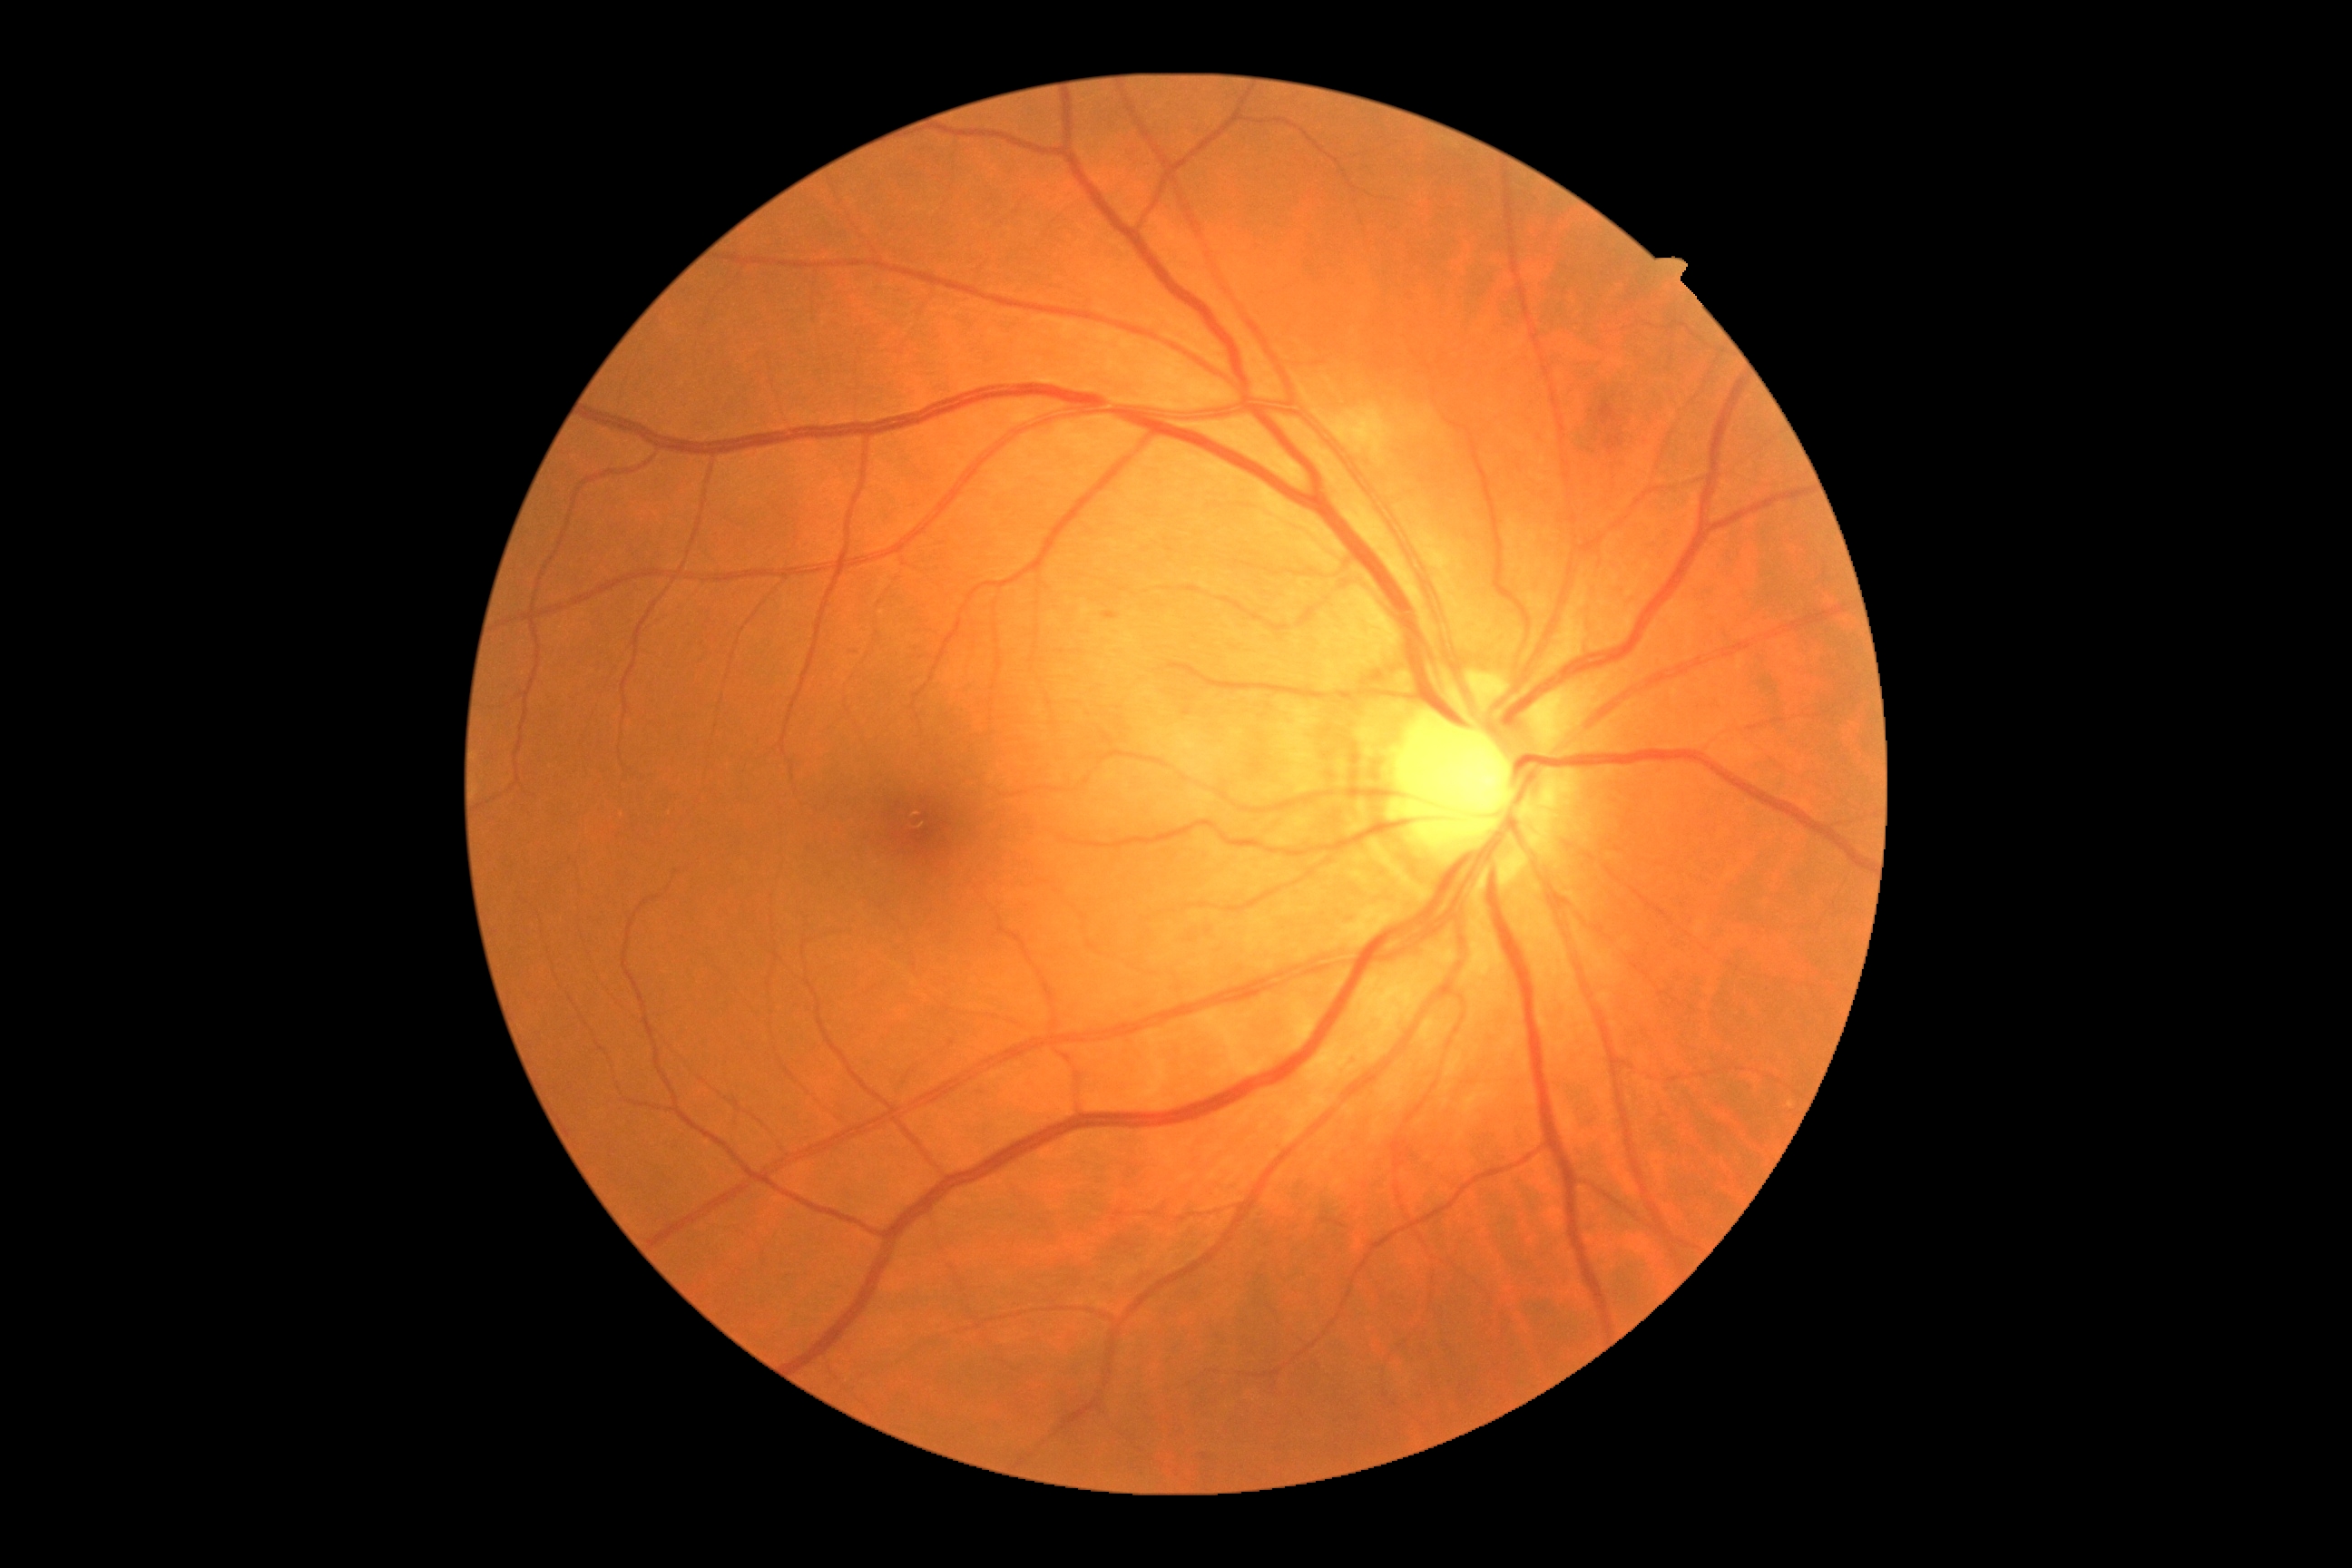
DR class: non-proliferative diabetic retinopathy. Diabetic retinopathy (DR): grade 2 (moderate NPDR).